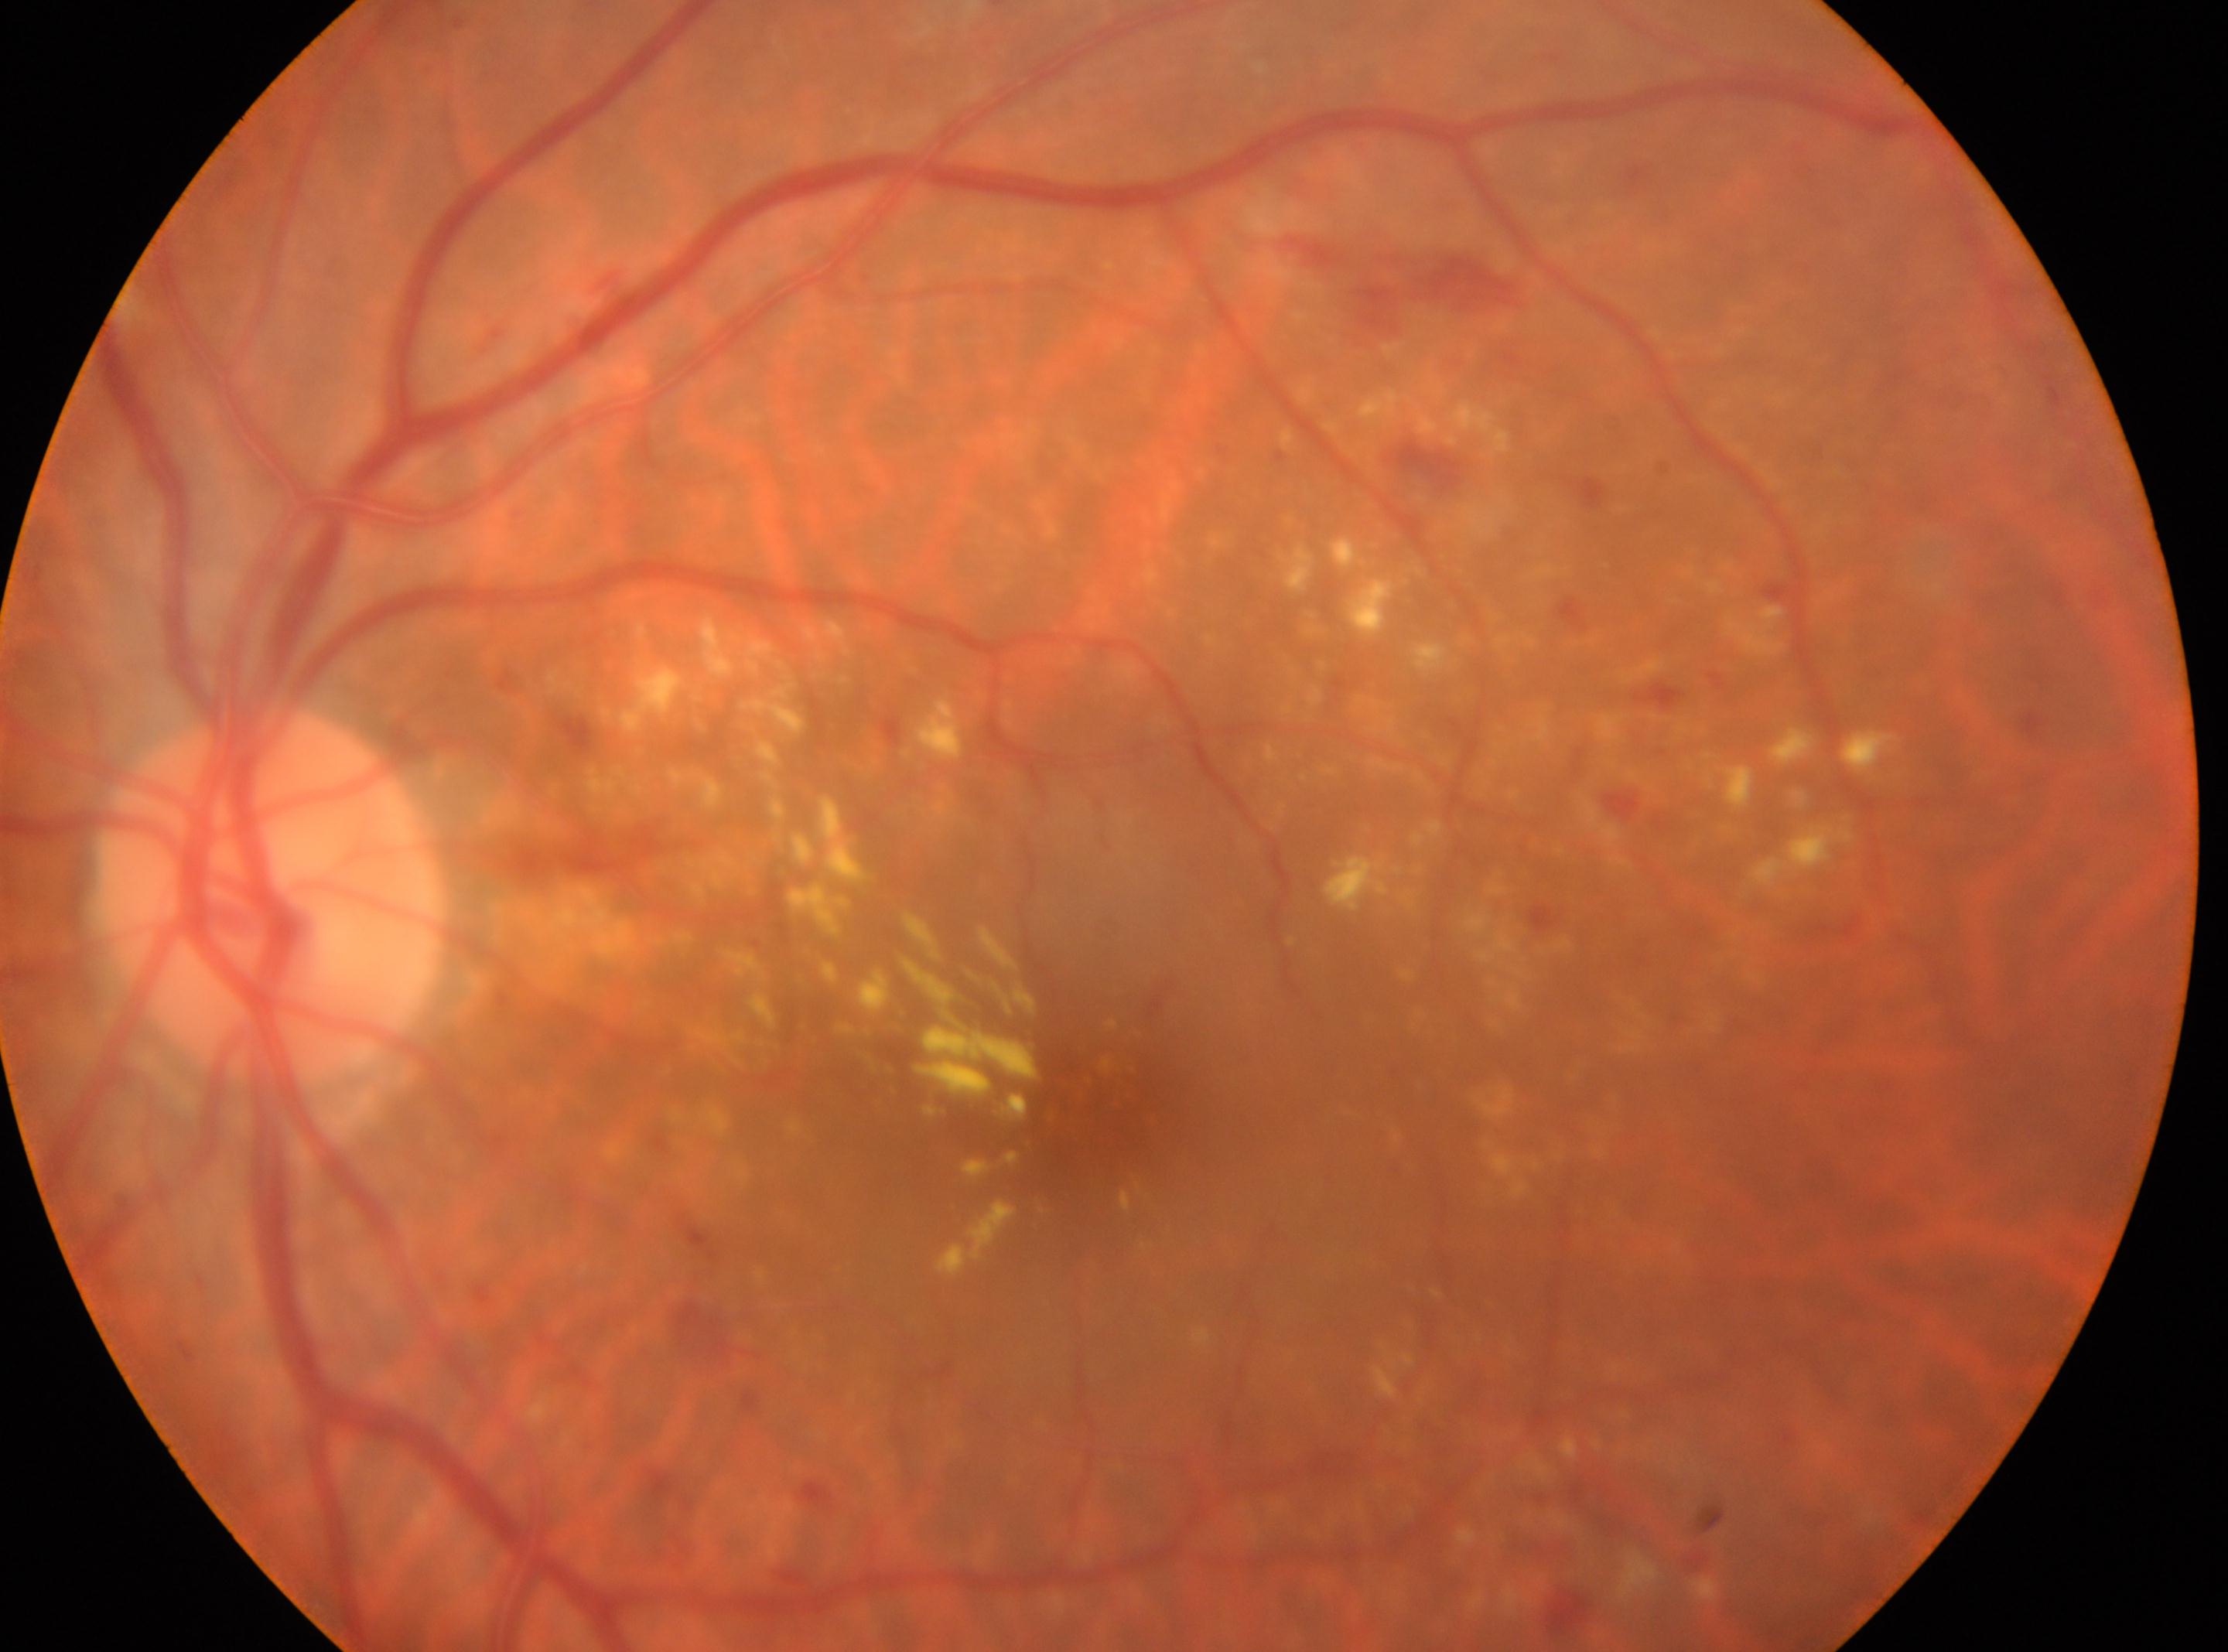

Foveal center: (1088,1123). ONH: (268,894). Eye: OS. DR grade is 2 (moderate NPDR) — more than just microaneurysms but less than severe NPDR.